Modified Davis classification
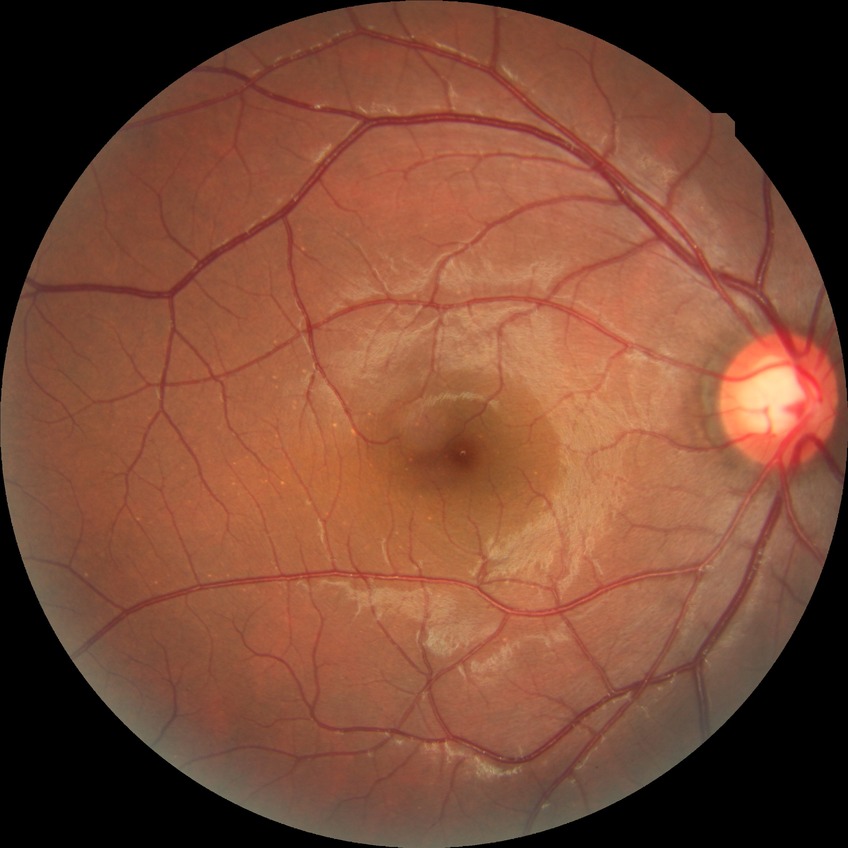

Annotations:
* diabetic retinopathy stage — no diabetic retinopathy